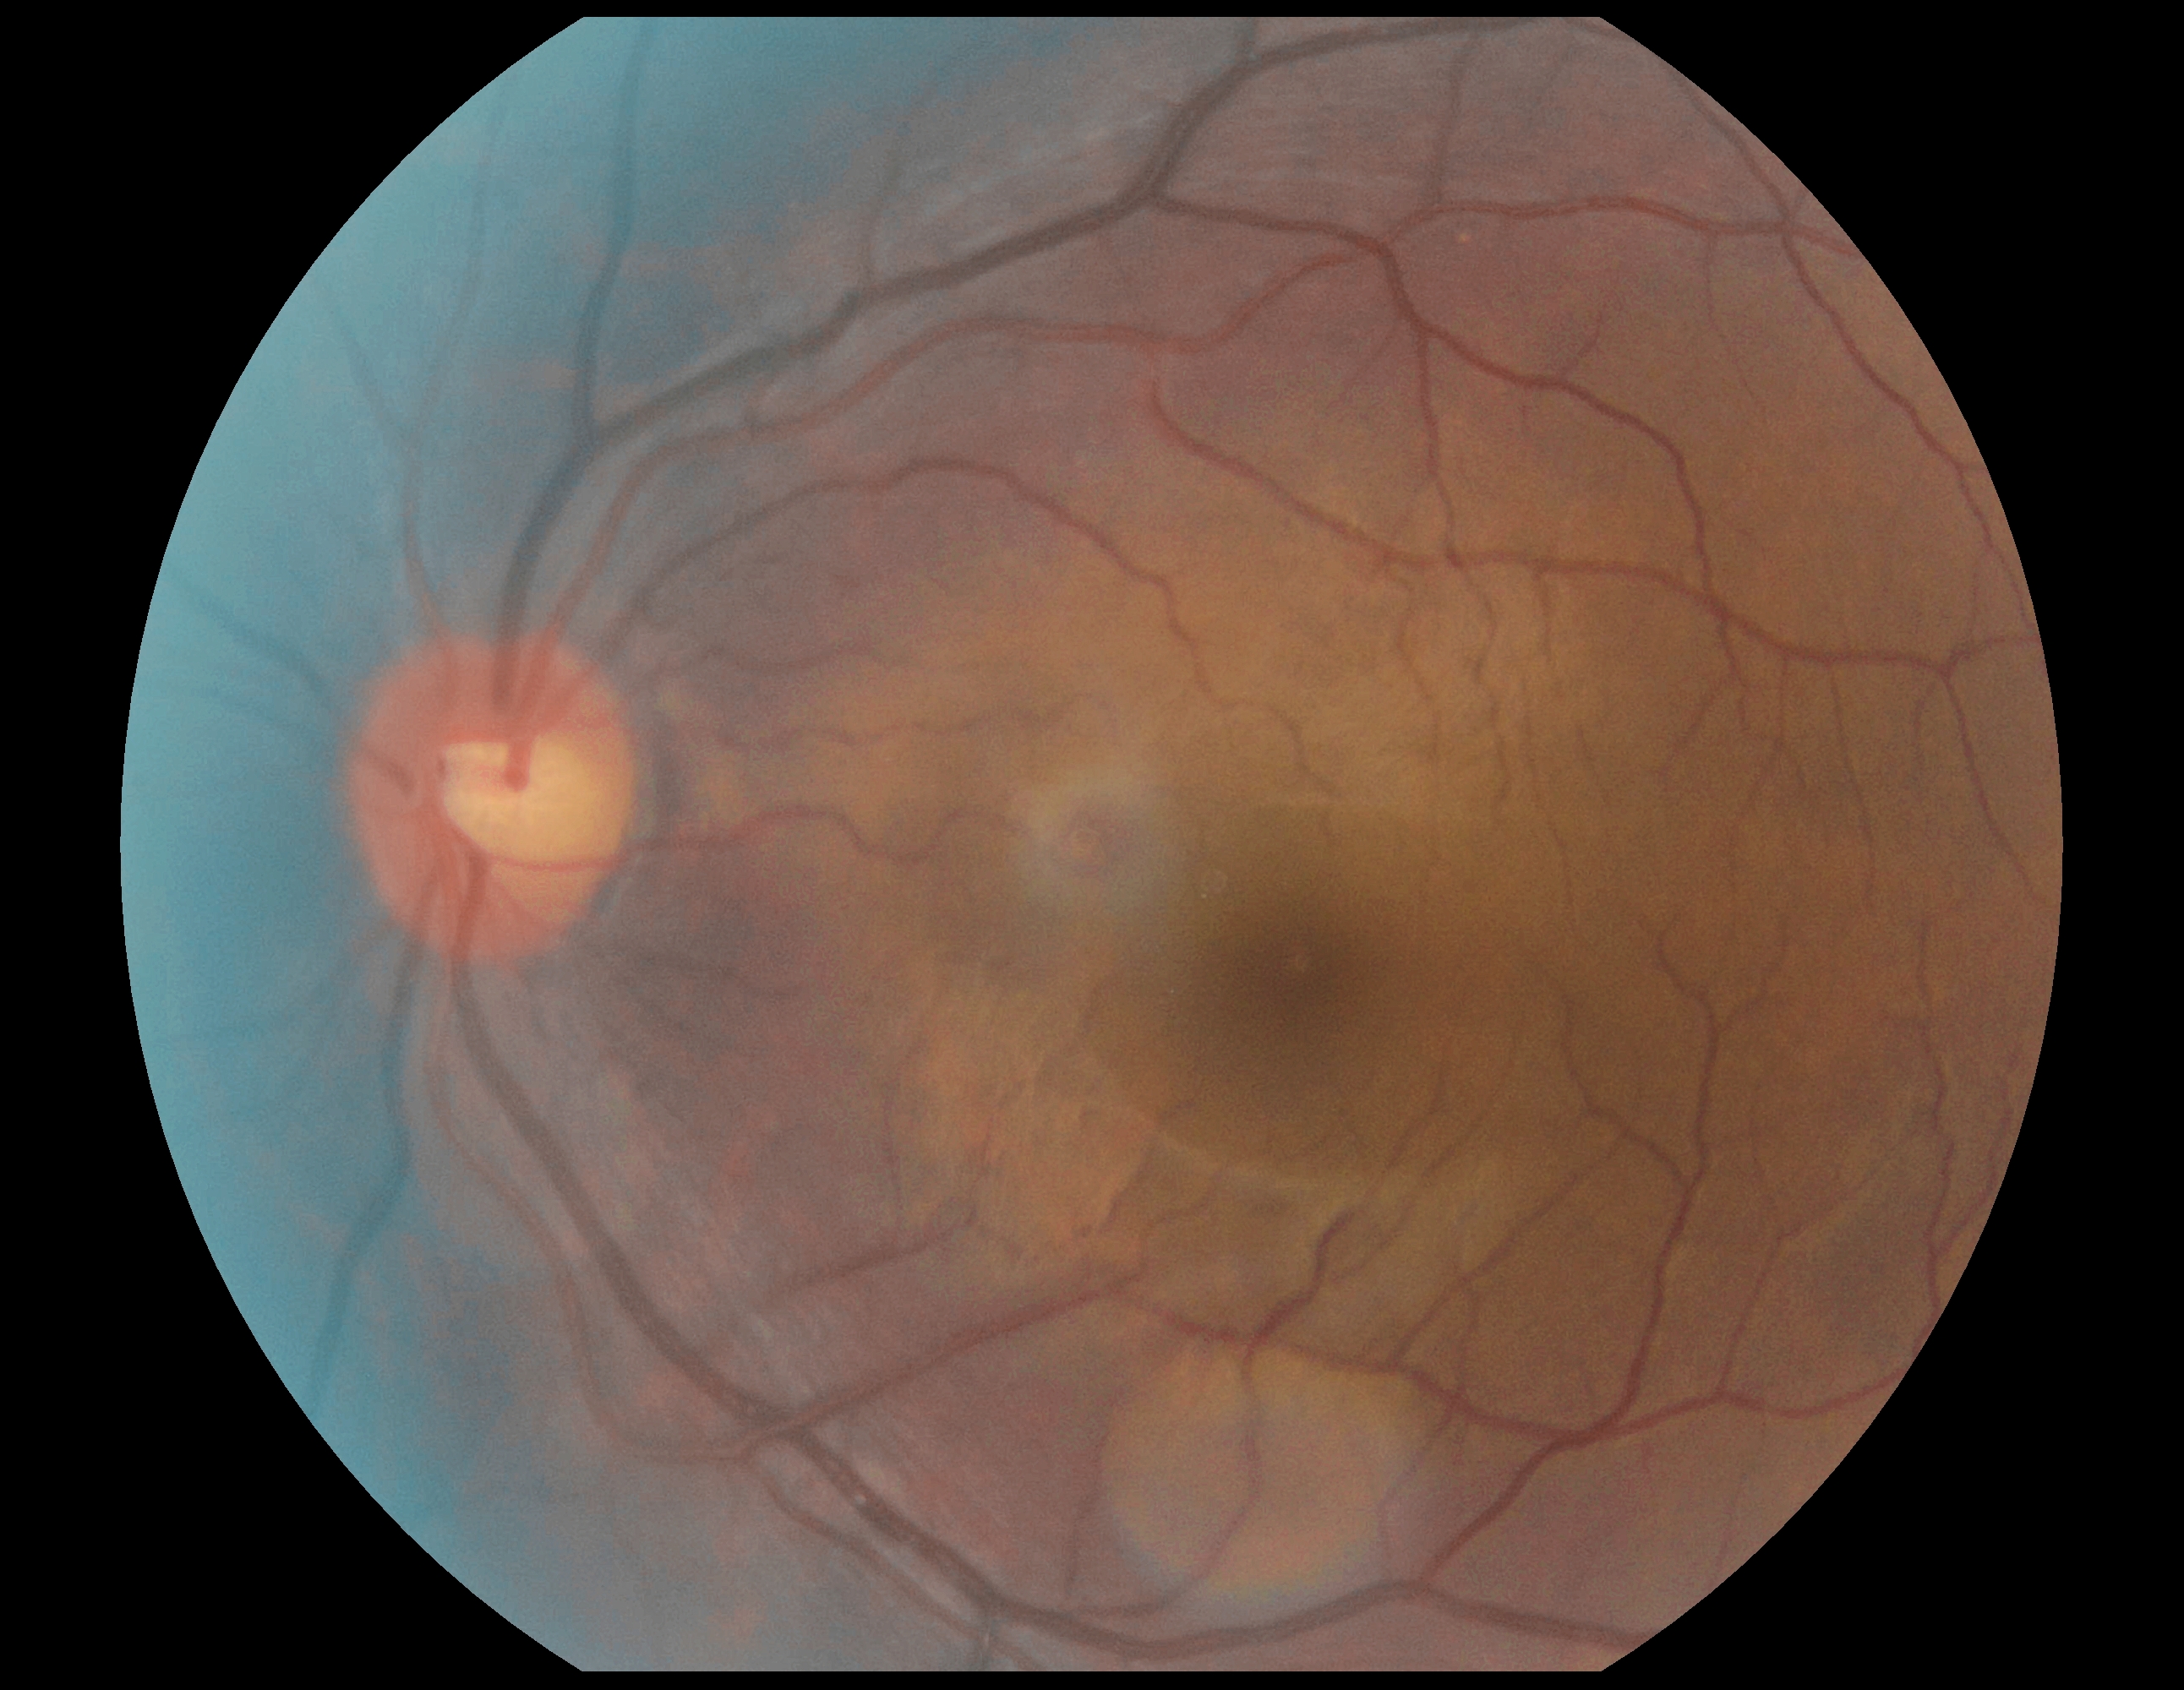 No signs of diabetic retinopathy. Retinopathy: no apparent retinopathy (grade 0).